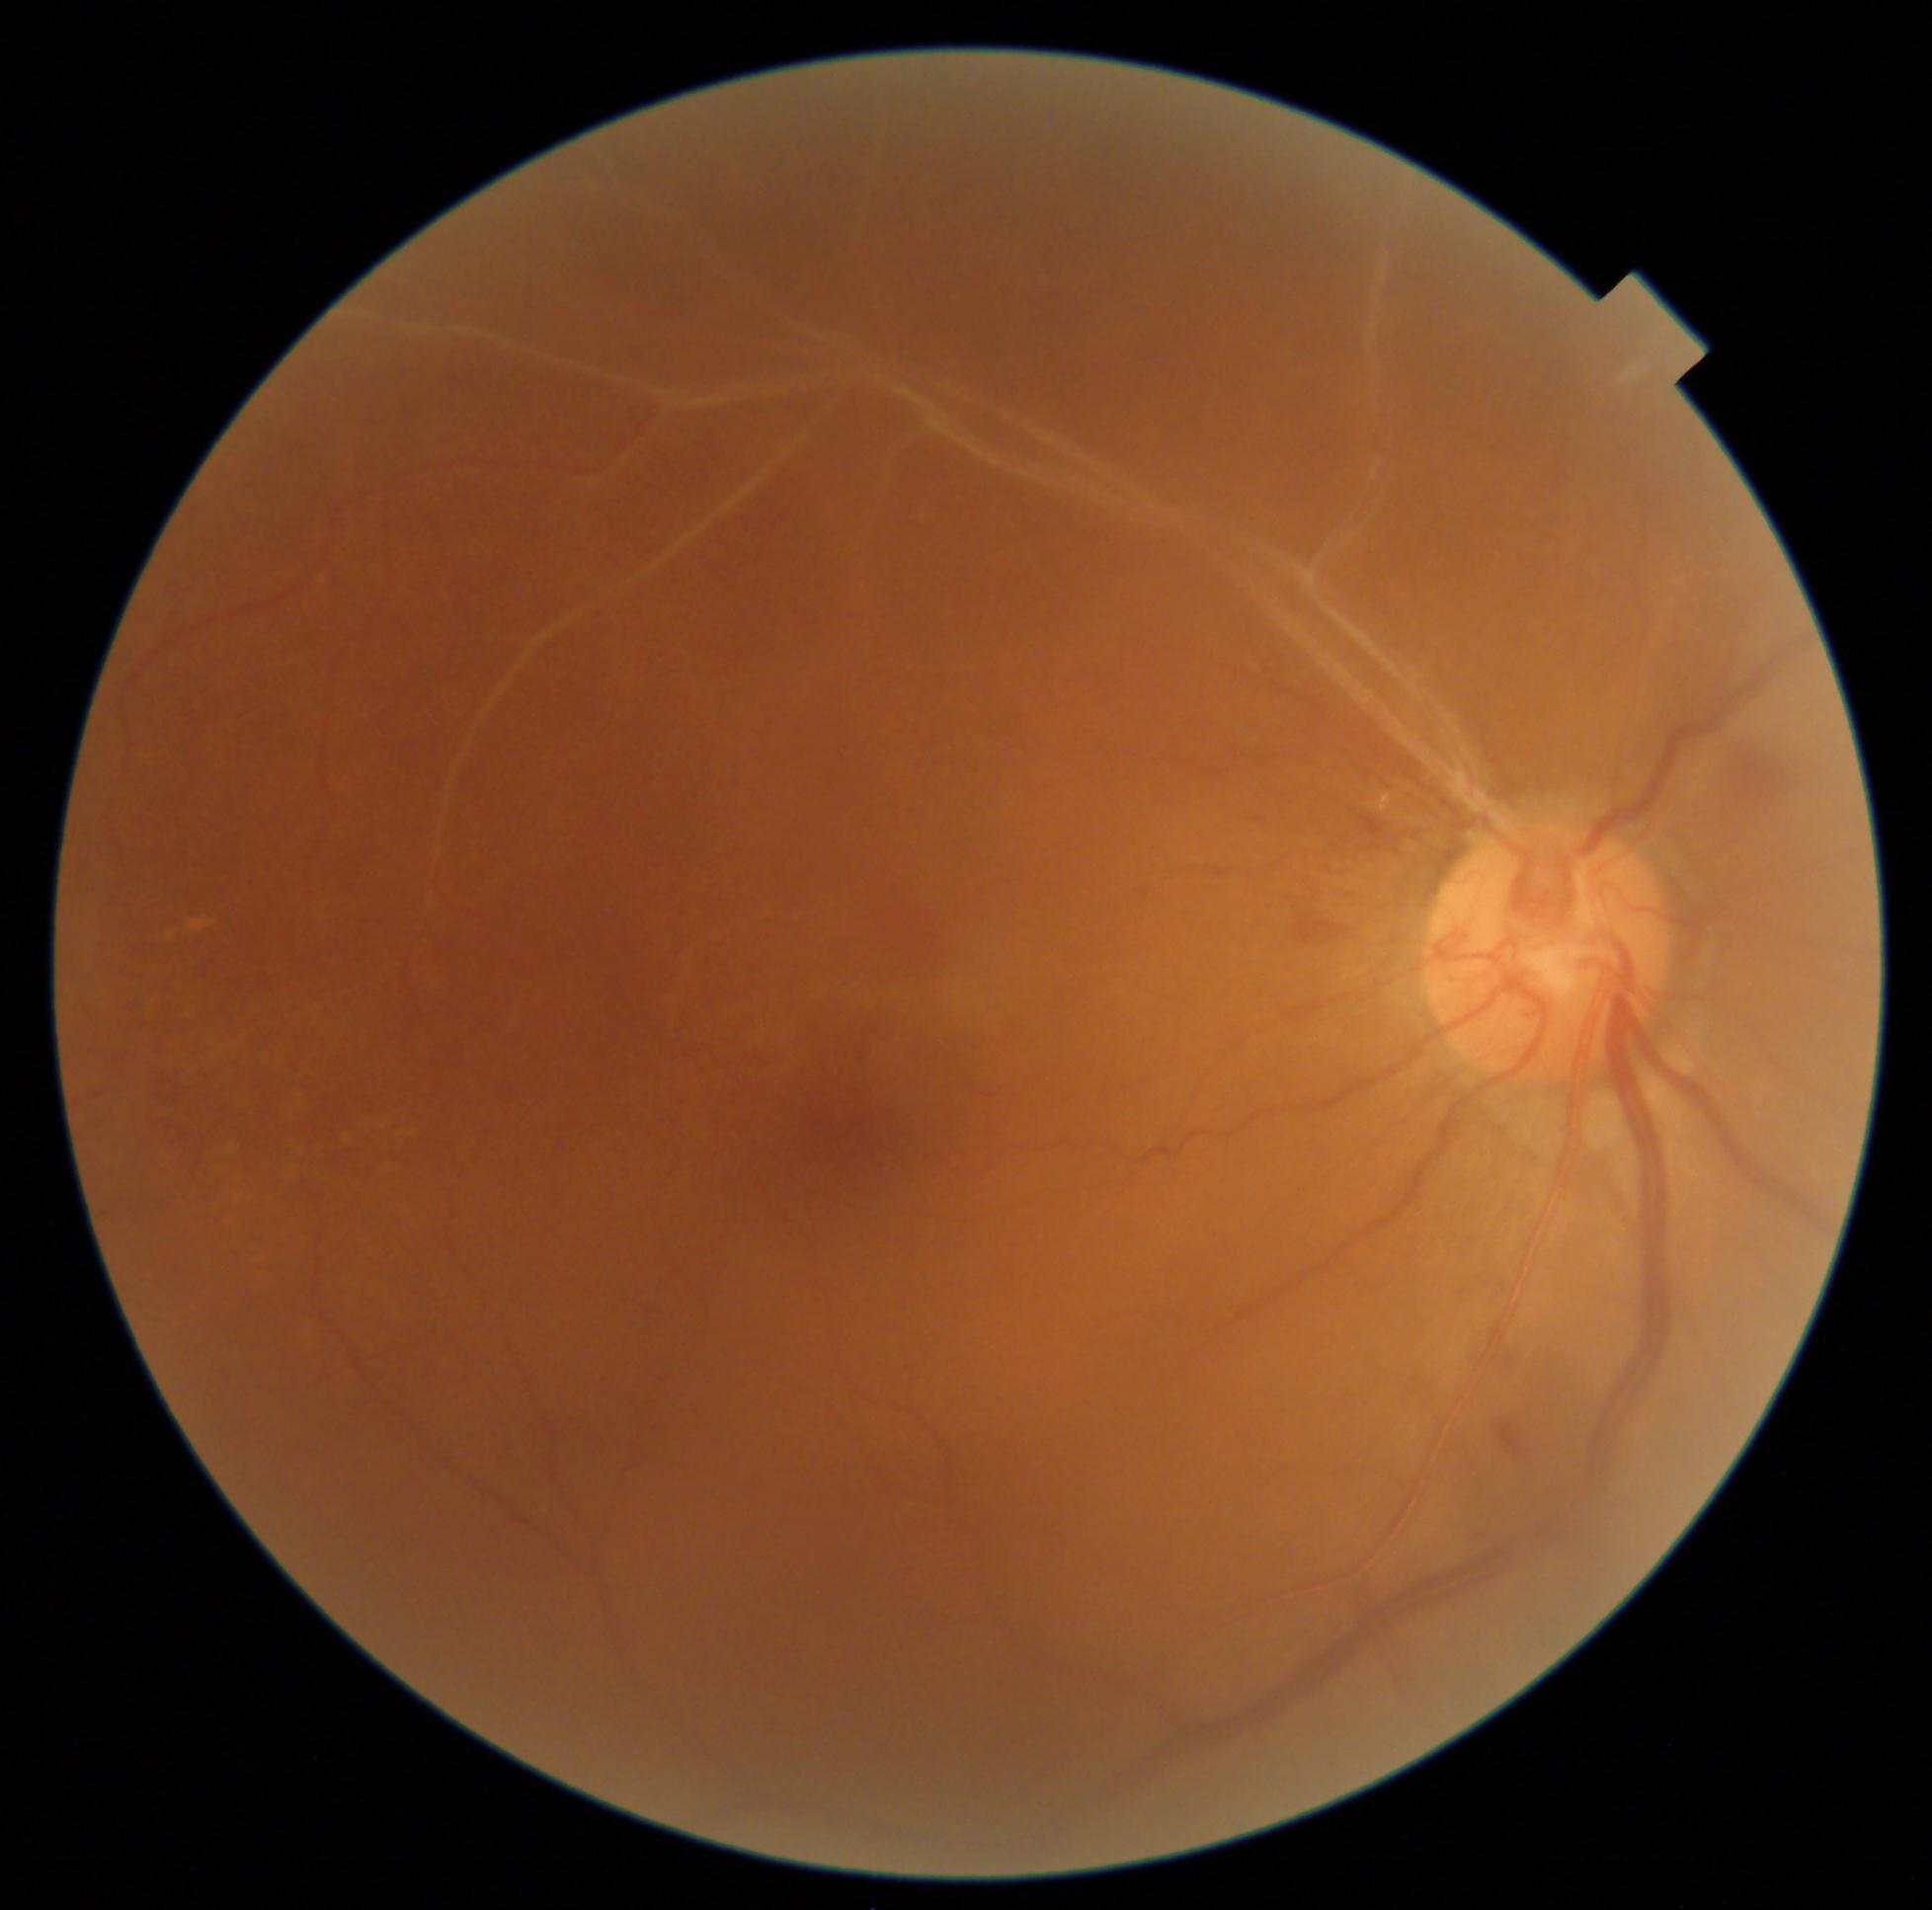
The retinopathy is classified as non-proliferative diabetic retinopathy.
DR grade: moderate NPDR (2) — more than just microaneurysms but less than severe NPDR.